45° FOV, image size 1380x1382, color fundus photograph:
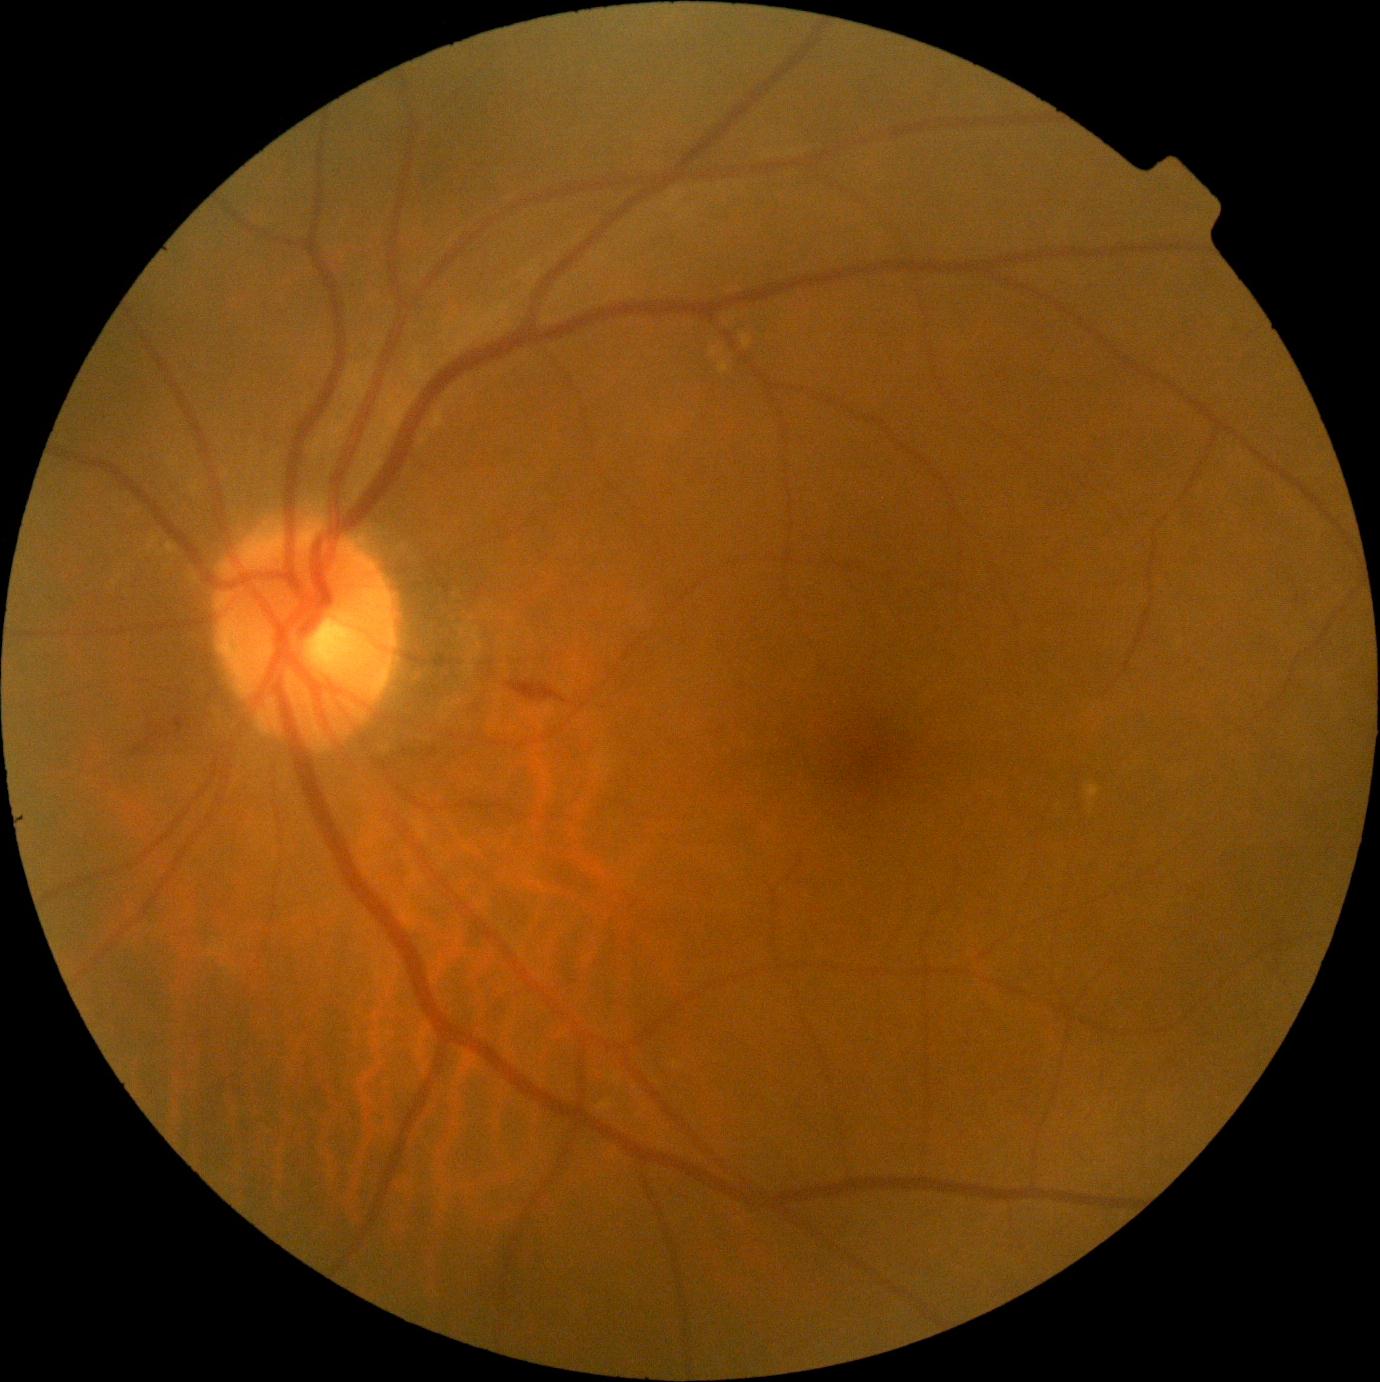 The retinopathy is classified as non-proliferative diabetic retinopathy. Diabetic retinopathy is grade 2.